NIDEK AFC-230 fundus camera, nonmydriatic, posterior pole photograph, 848x848px, diabetic retinopathy graded by the modified Davis classification, FOV: 45 degrees:
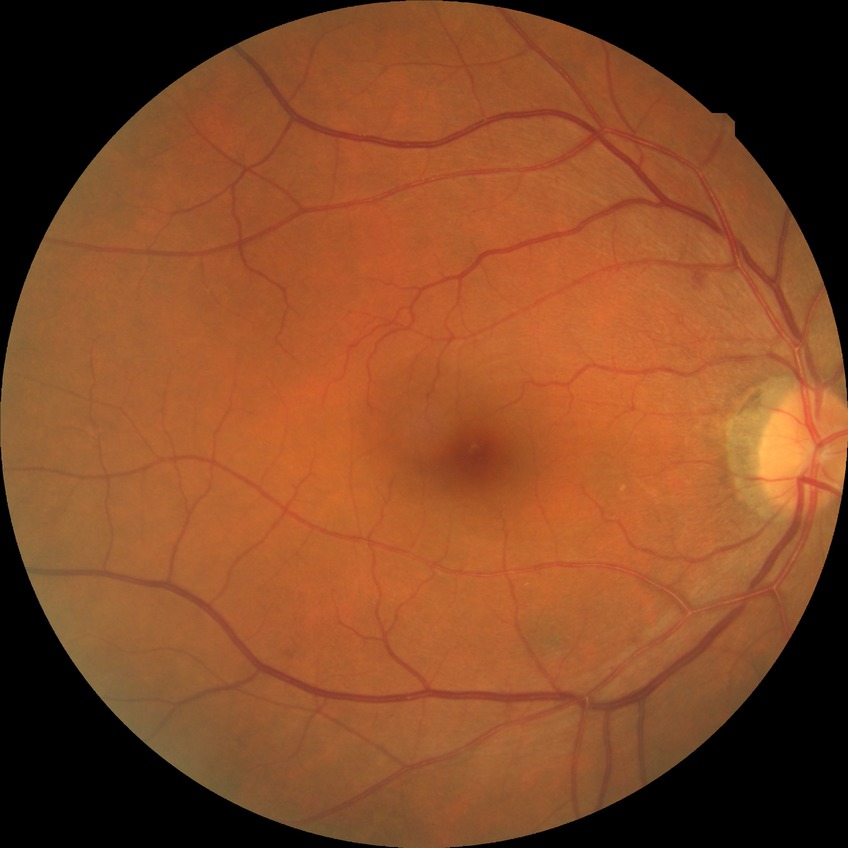

DR stage is SDR.